1936 x 1296 pixels.
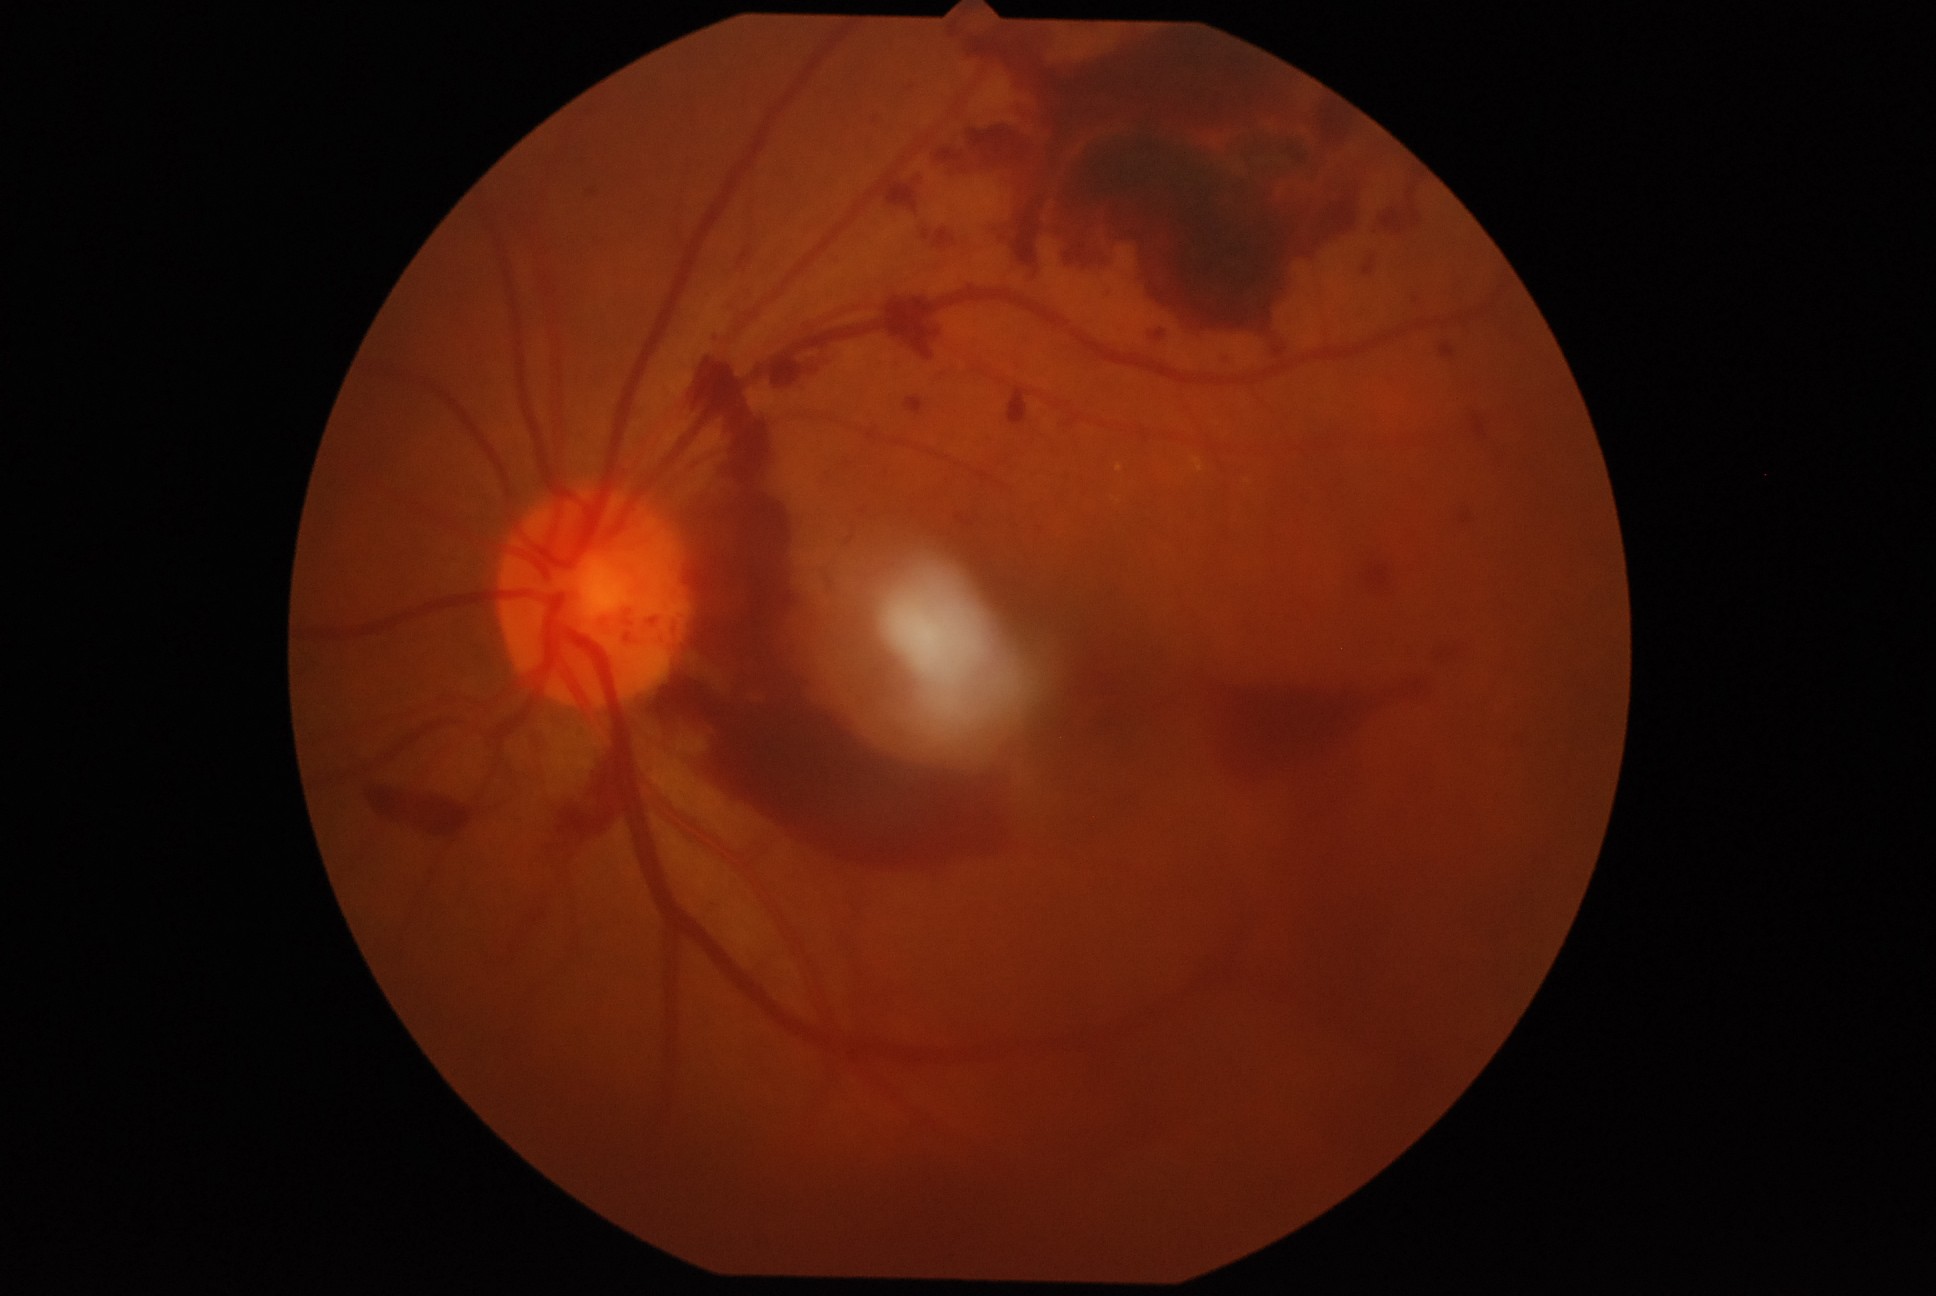
DR severity is PDR (grade 4).